640 by 480 pixels; wide-field fundus image from infant ROP screening; 130° field of view (Clarity RetCam 3): 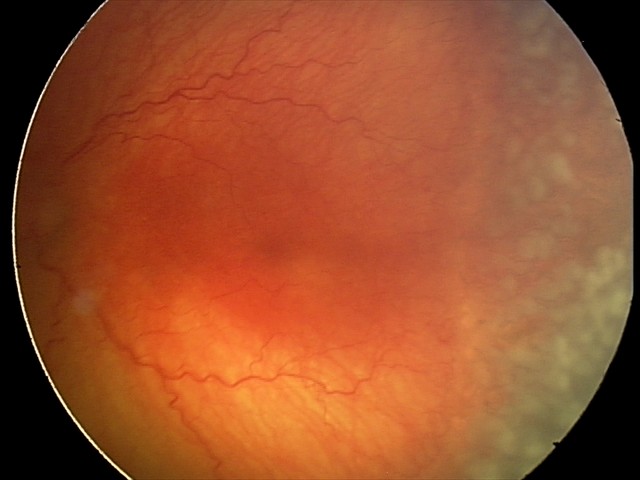 Series diagnosed as aggressive retinopathy of prematurity — rapidly progressive severe ROP with prominent plus disease, often without classic stage progression.
Plus disease present.